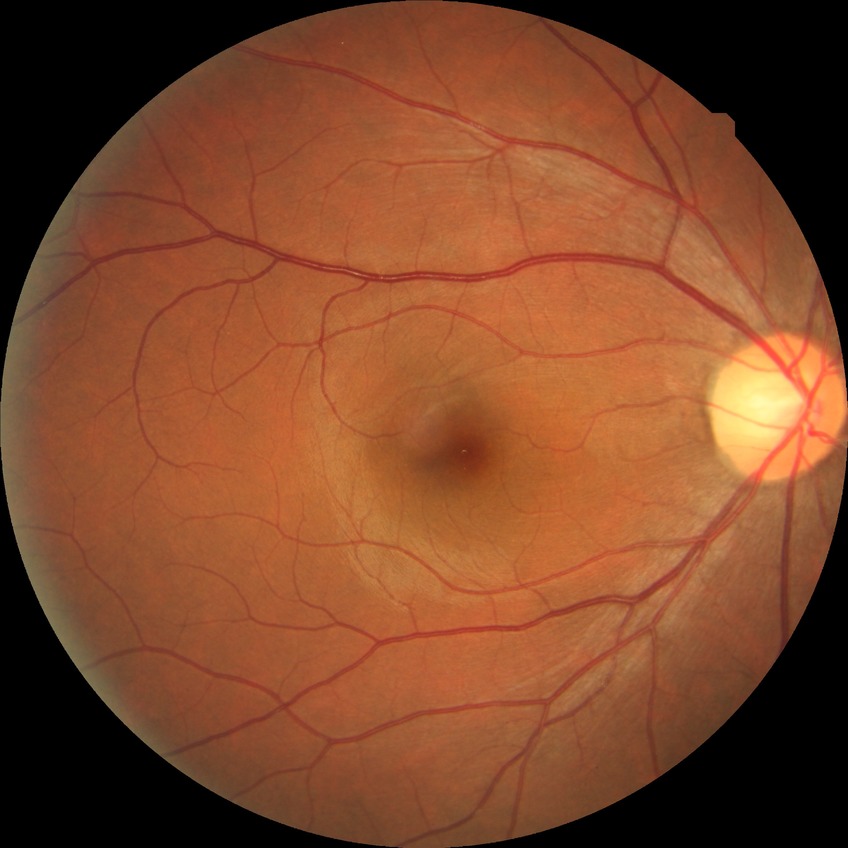
davis_grade: no diabetic retinopathy (NDR)